Captured after pupil dilation · color fundus photograph · 2361 by 1568 pixels: 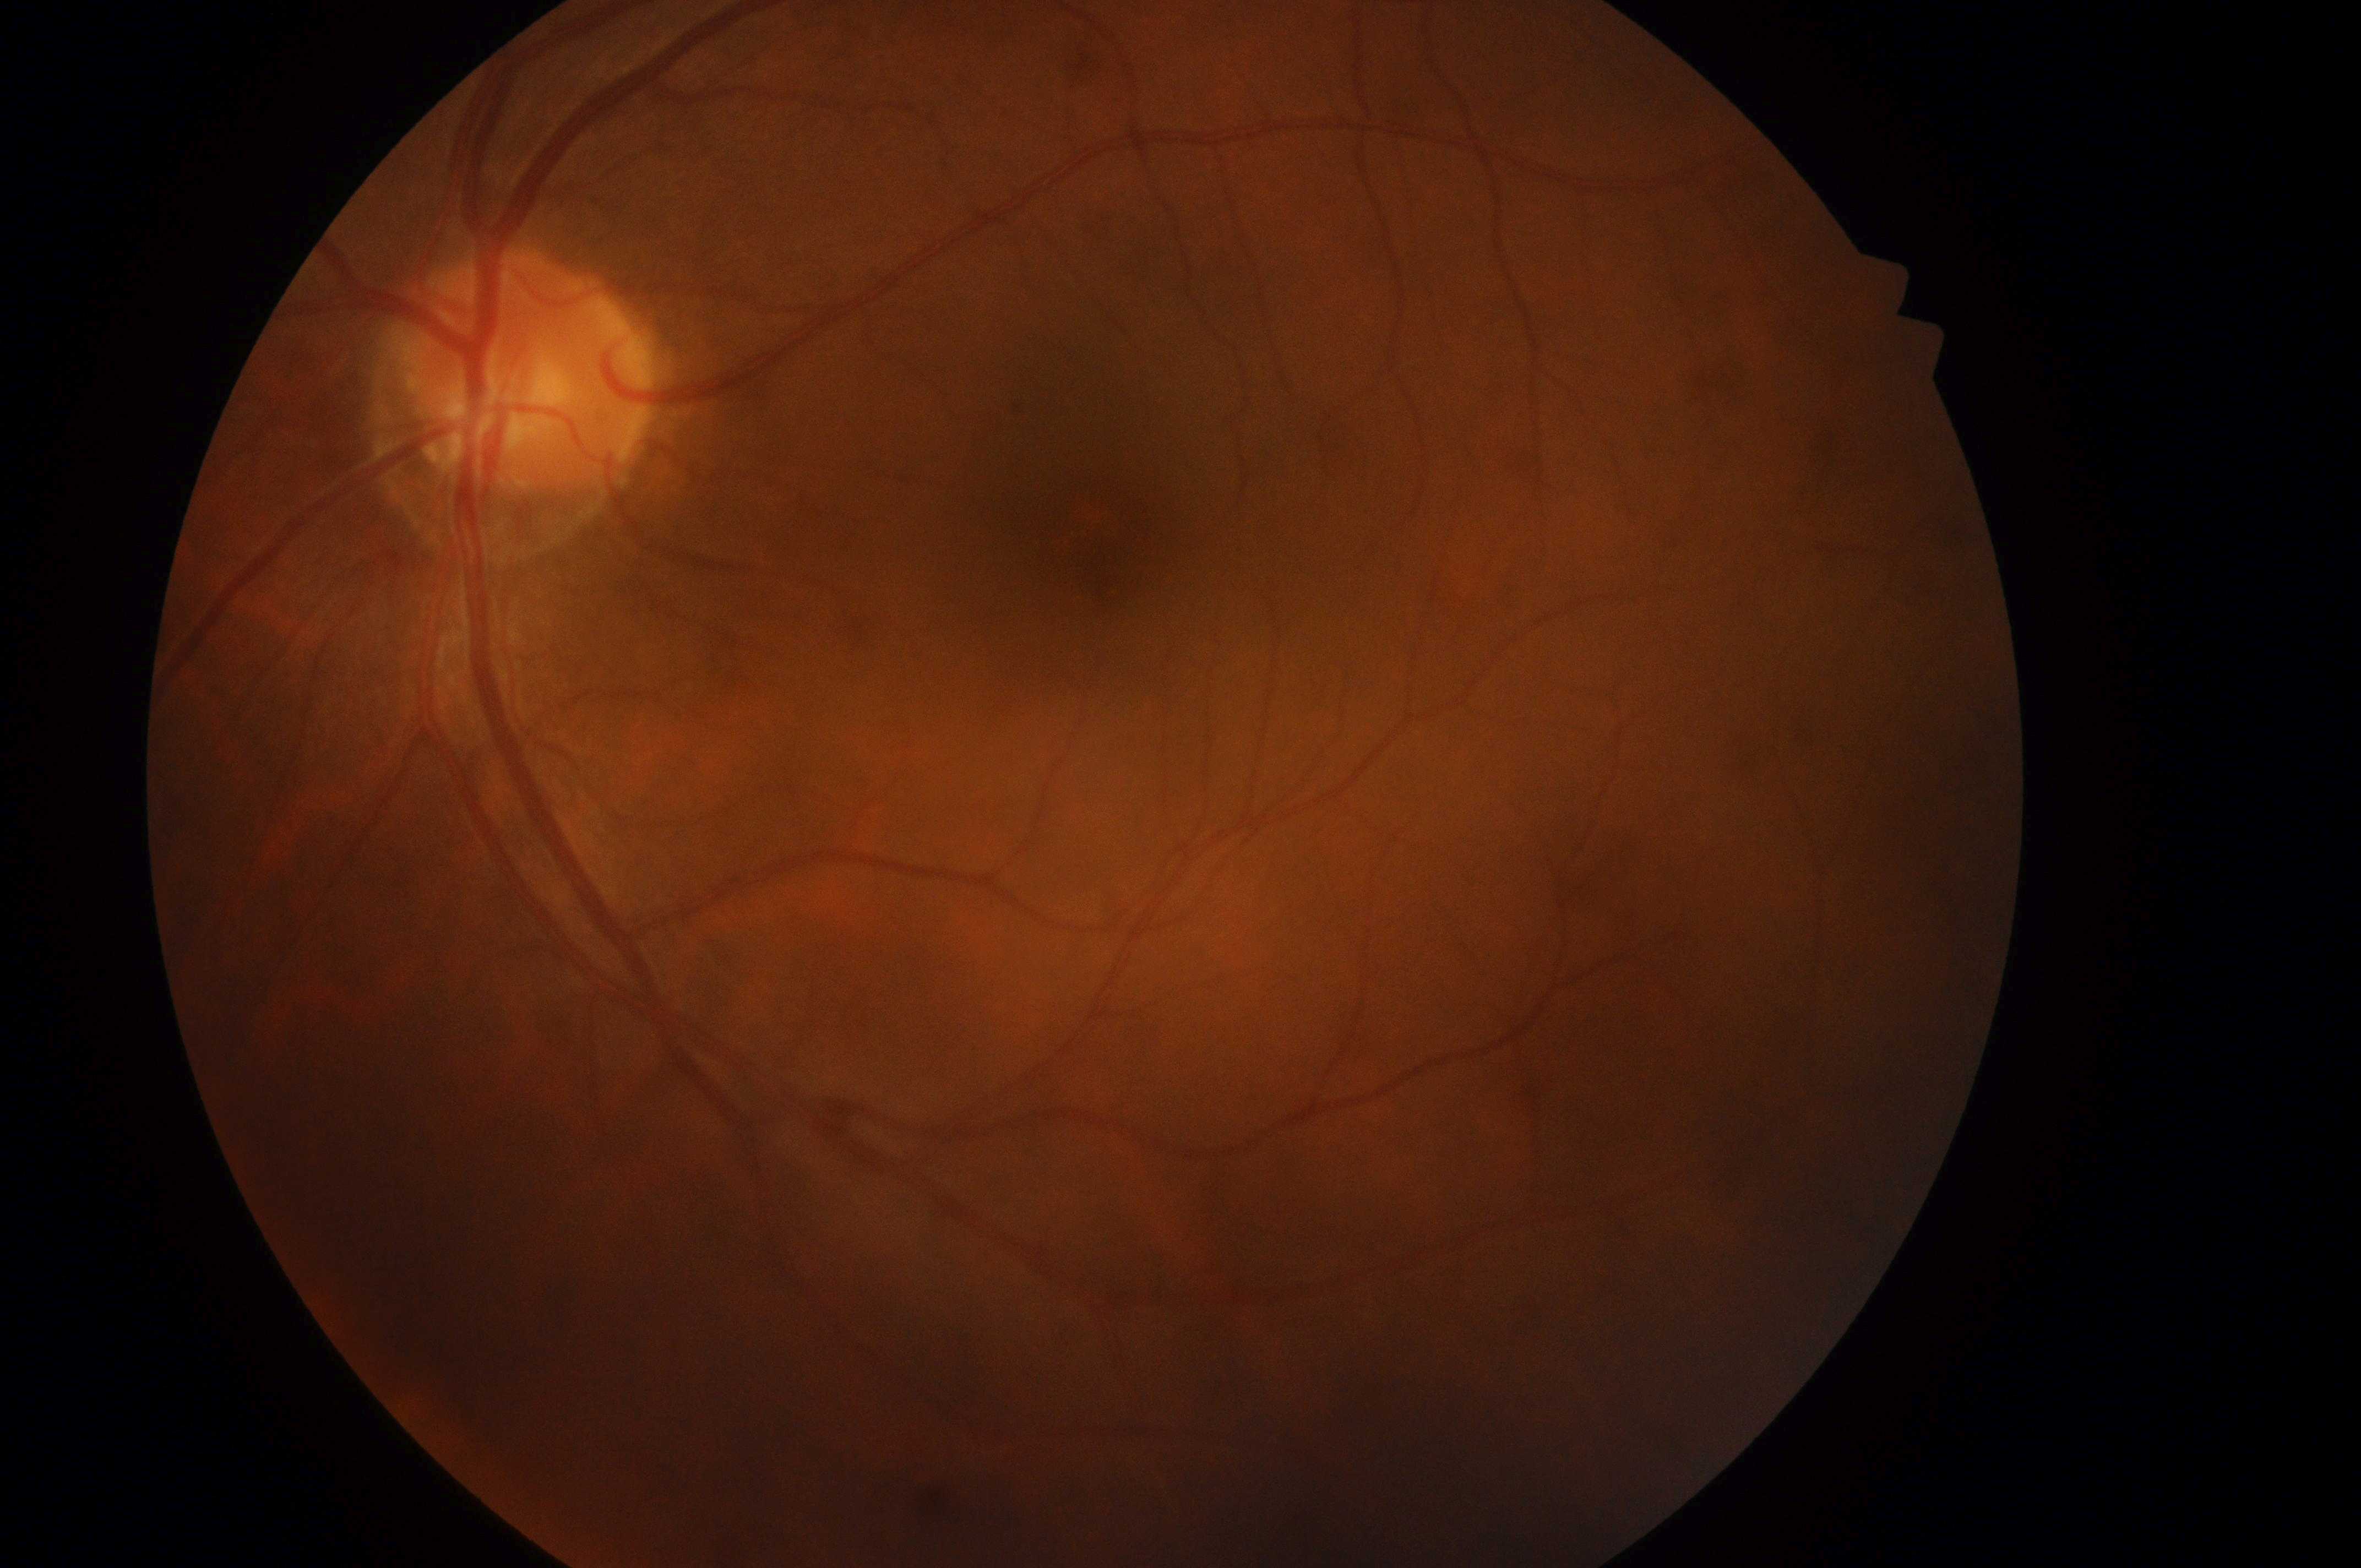

Q: What is the DR grade?
A: 0
Q: What is the DME risk grade?
A: grade 0
Q: Optic disc center?
A: [521, 383]
Q: DR/DME impression?
A: No diabetic retinopathy; no macular edema risk
Q: Where is the fovea?
A: [1116, 550]
Q: Right or left eye?
A: left